2228 by 1652 pixels
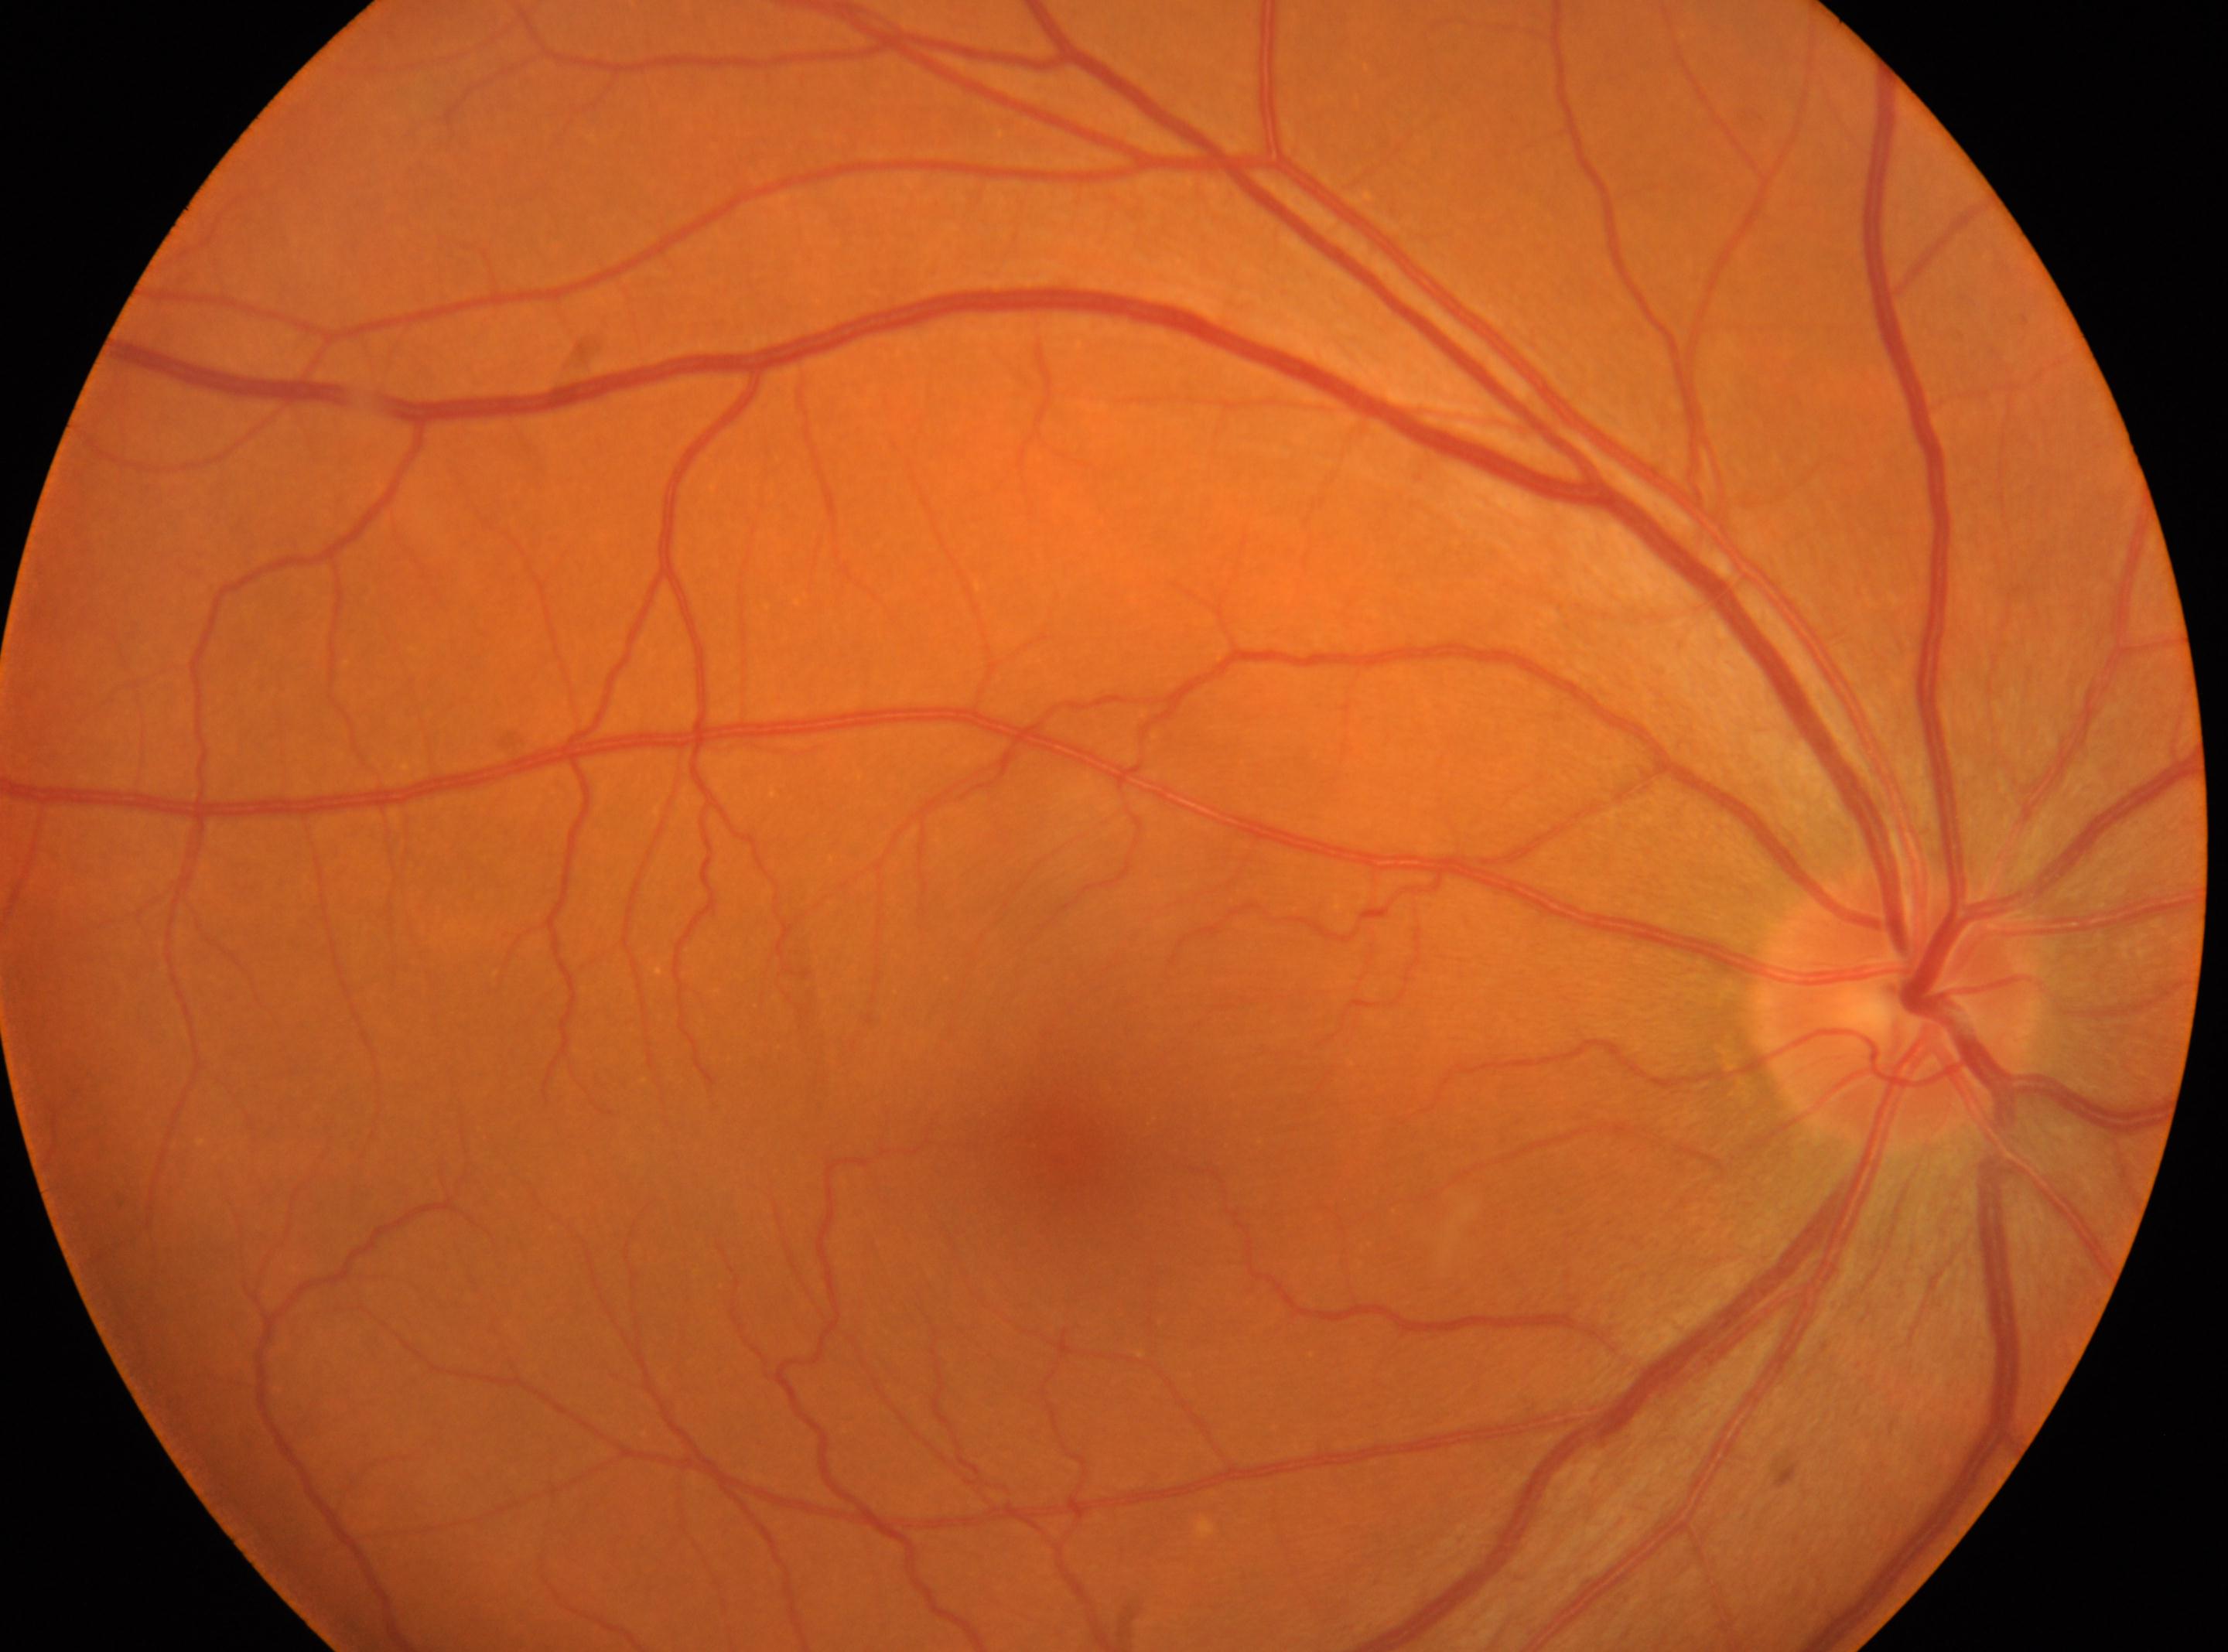 optic disc center@(x: 1896, y: 1004); No diabetic retinal disease findings; retinopathy@no apparent retinopathy (grade 0) — no visible signs of diabetic retinopathy; right eye; fovea centralis@(x: 1066, y: 1155).